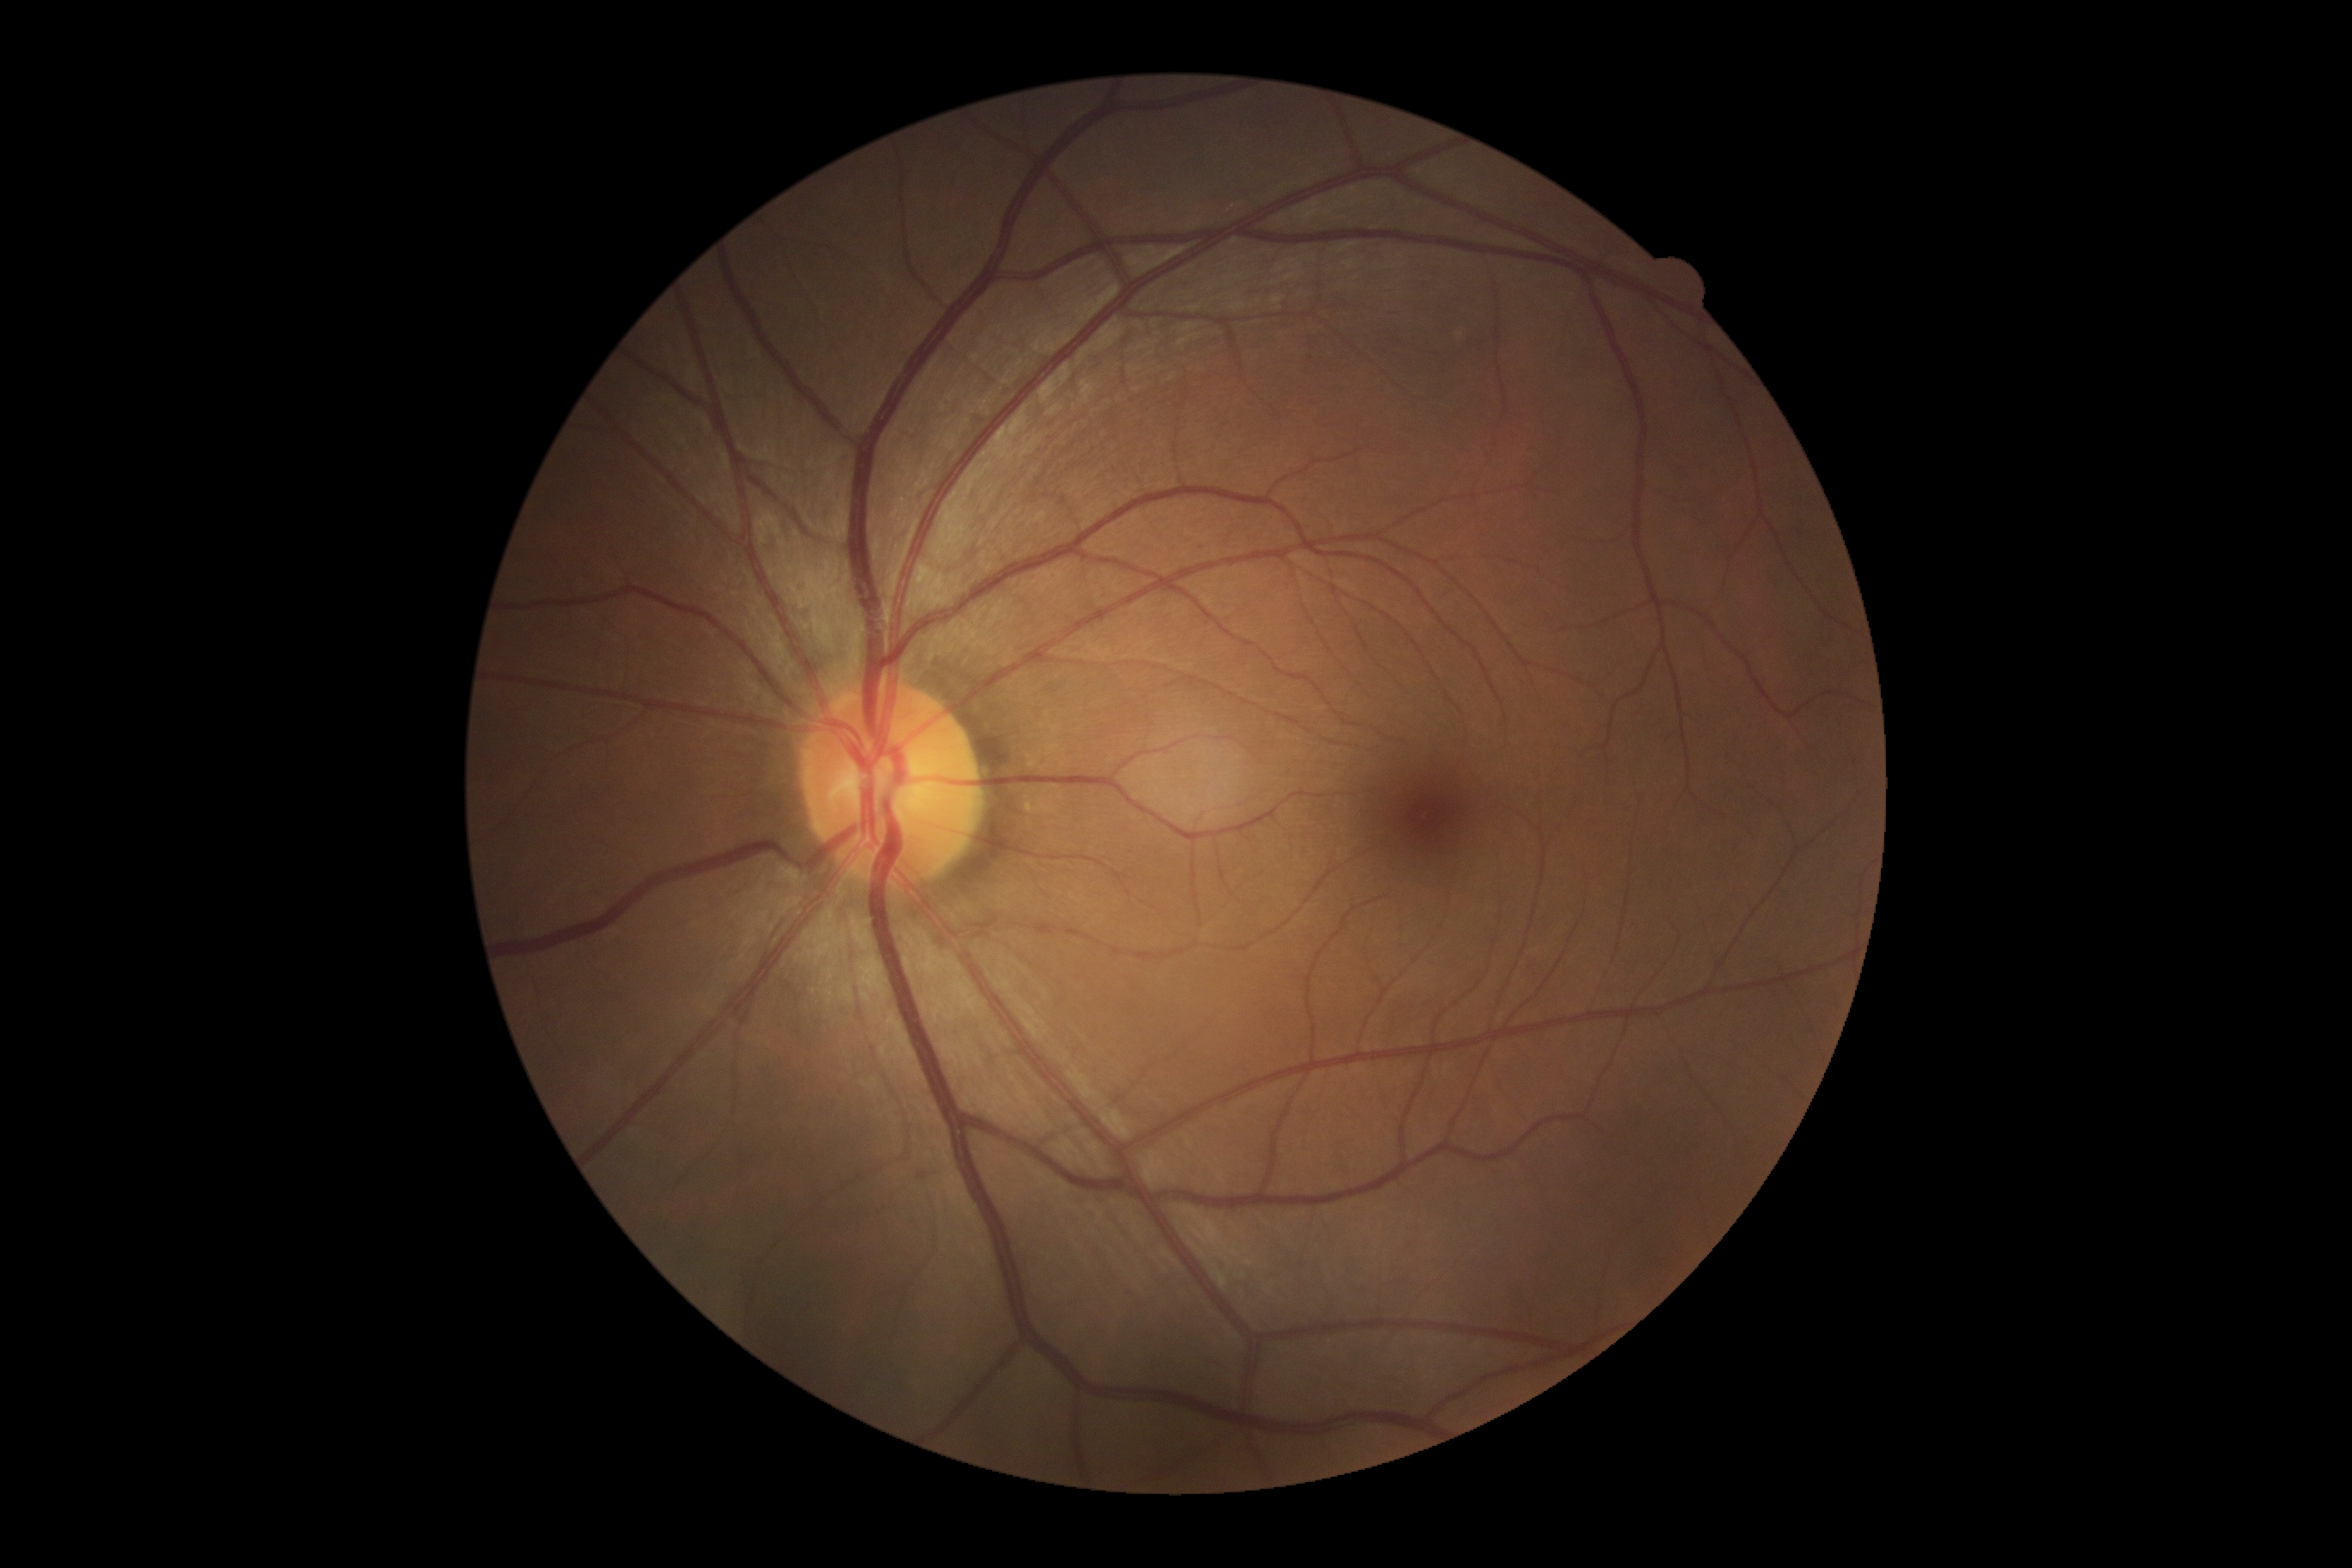
Findings:
– diabetic retinopathy (DR) — grade 0 — no visible signs of diabetic retinopathy